Graded on the modified Davis scale · 45 degree fundus photograph.
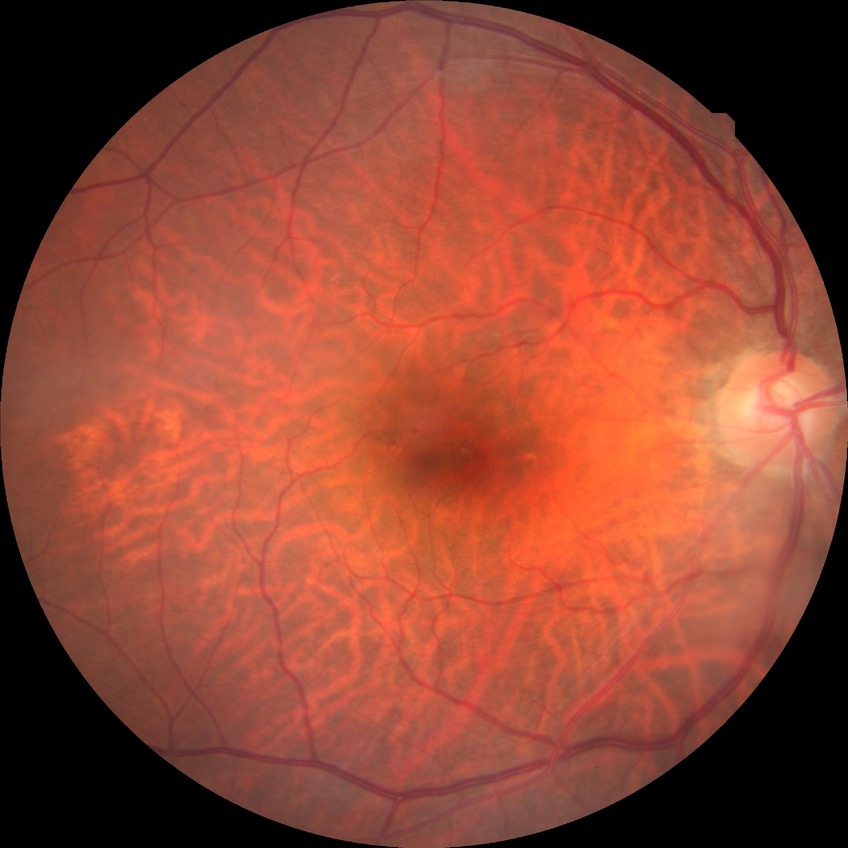
diabetic retinopathy (DR): simple diabetic retinopathy (SDR)